Wide-field contact fundus photograph of an infant · 640 by 480 pixels.
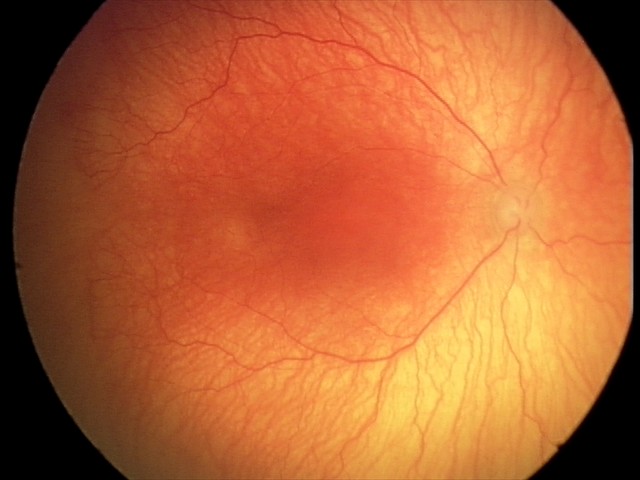

Series diagnosed as aggressive retinopathy of prematurity.
Plus disease present.